Camera: NIDEK AFC-230
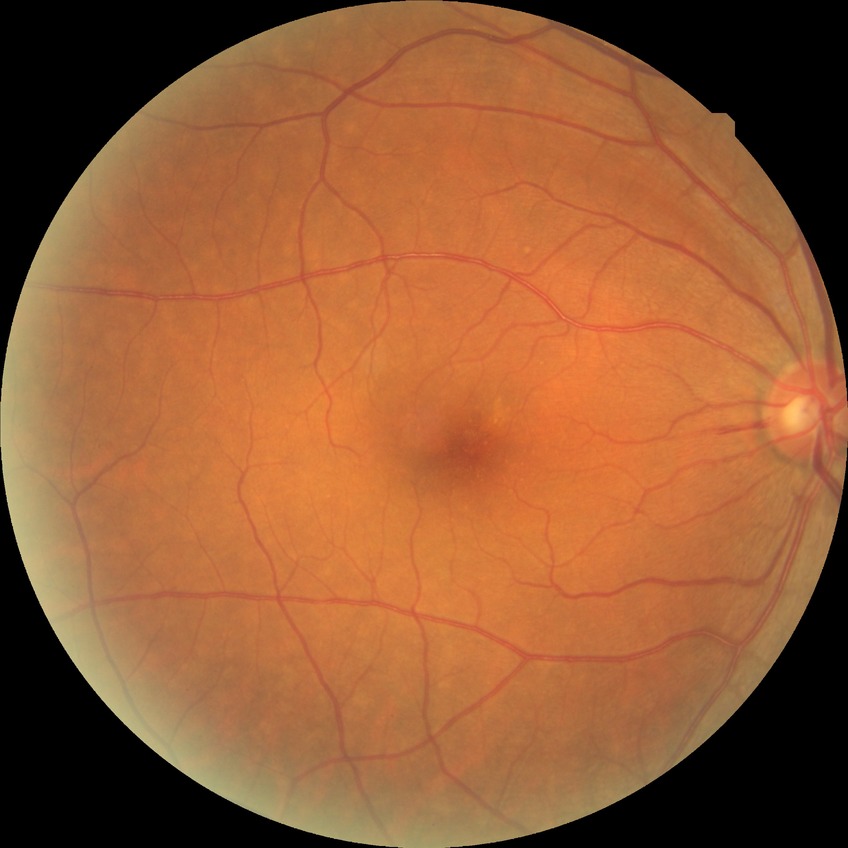
Diabetic retinopathy (DR): no diabetic retinopathy (NDR).